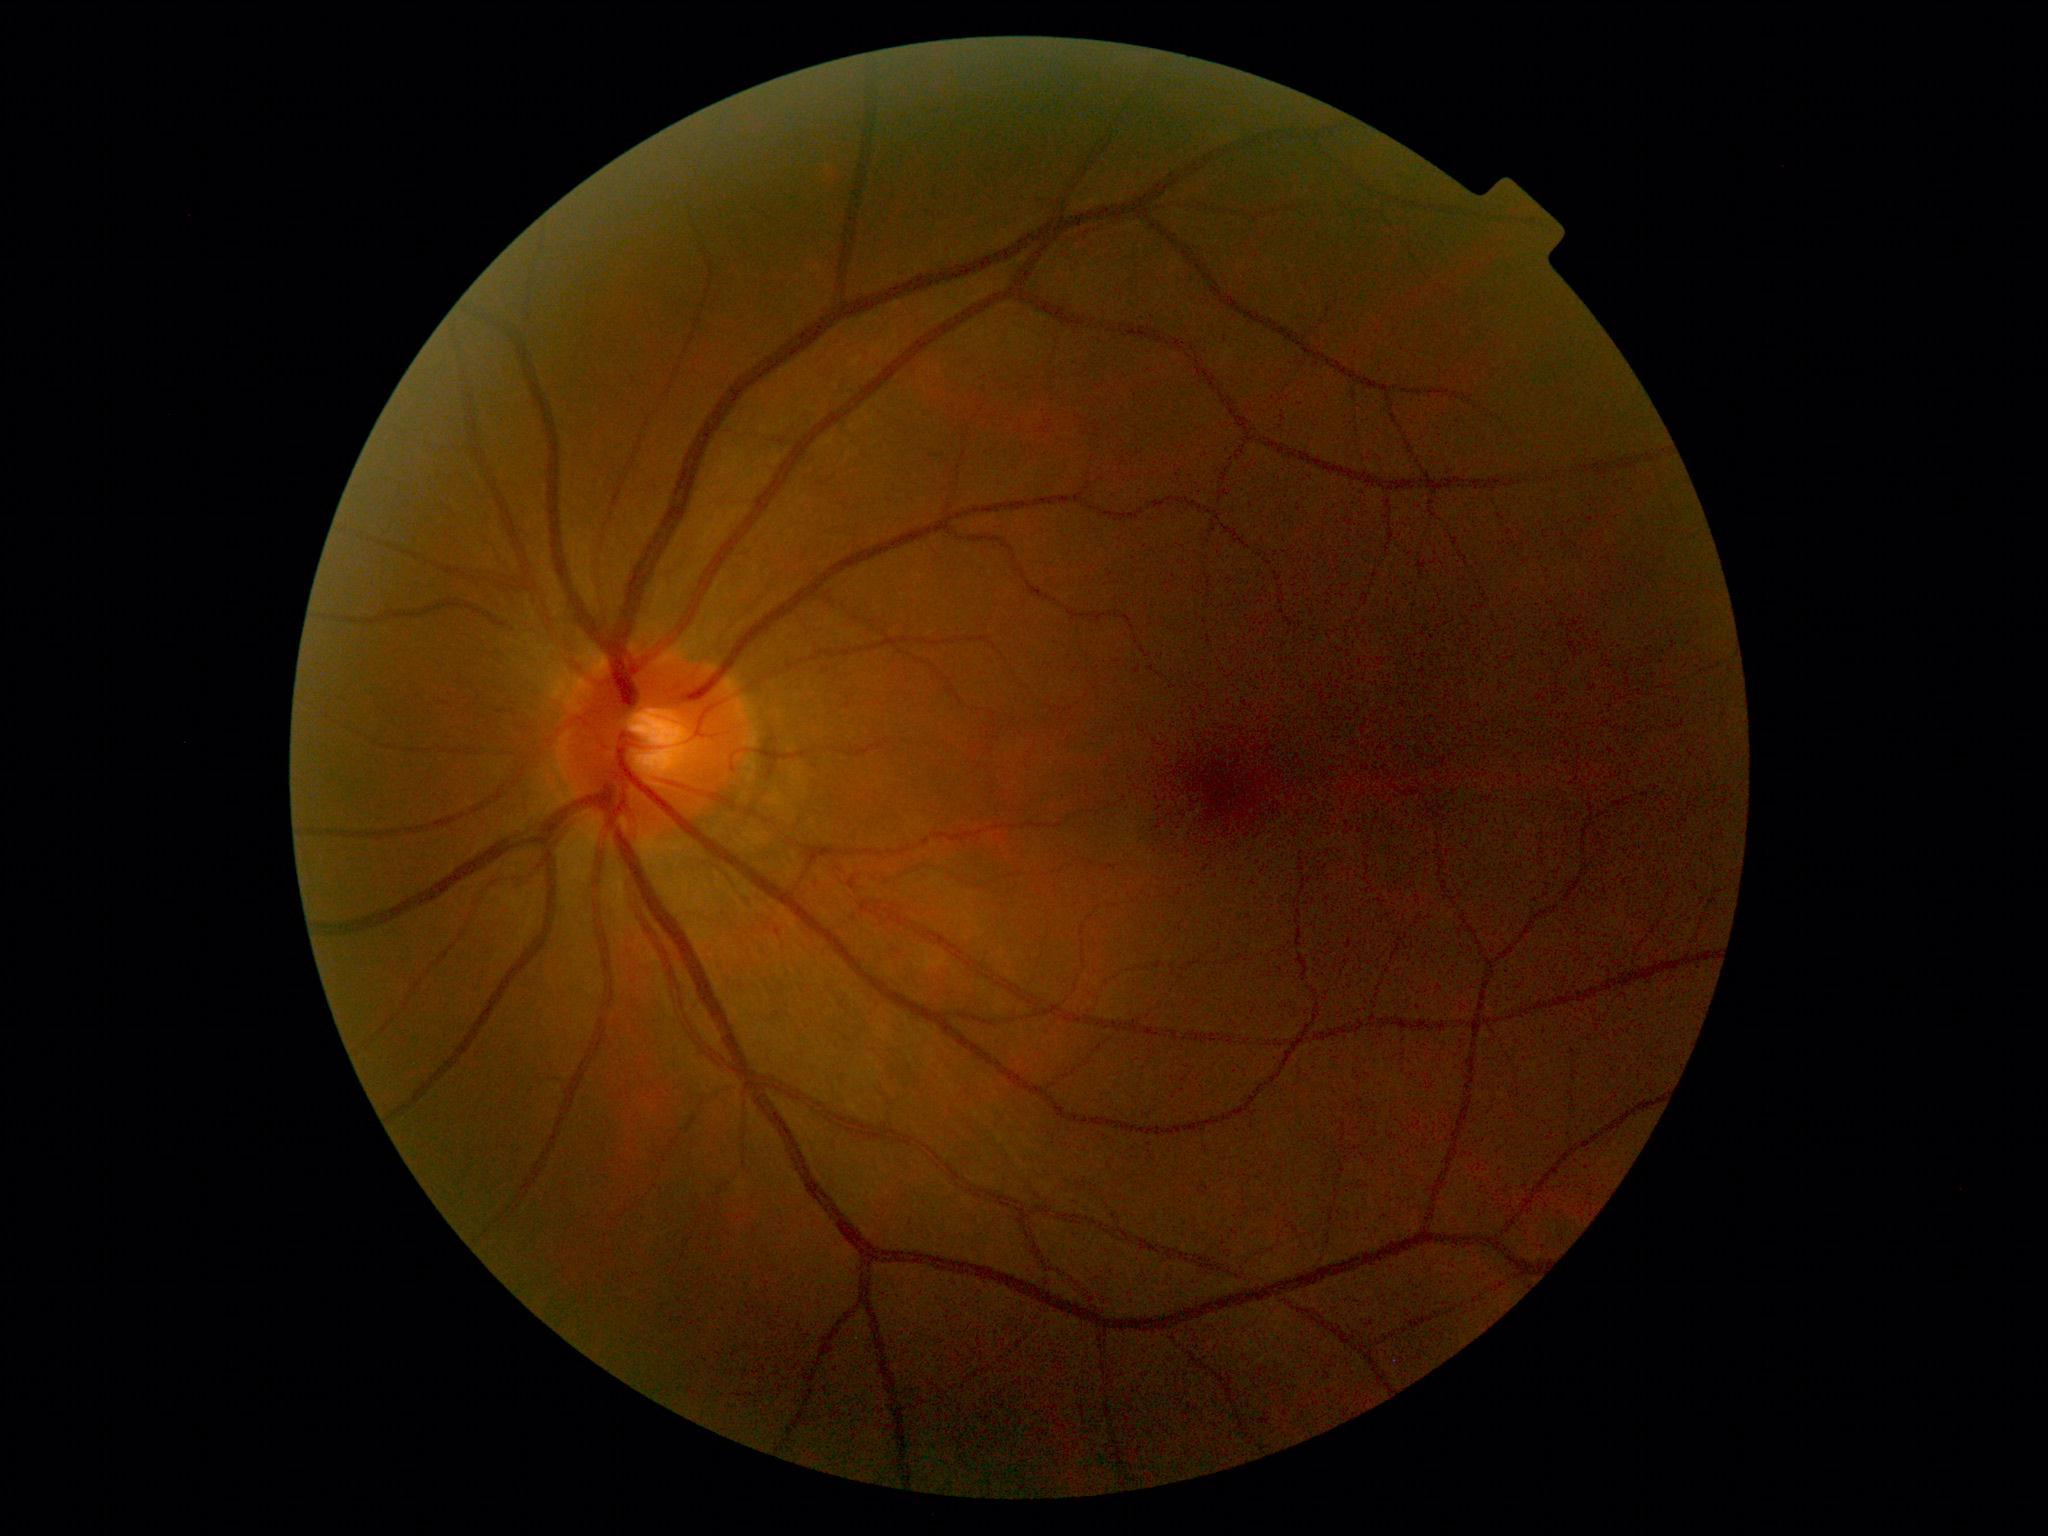

DR=1/4.